Non-mydriatic, 240x240
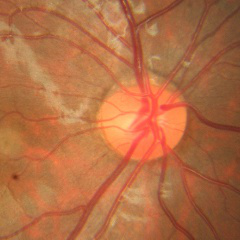 Findings consistent with no glaucomatous changes.